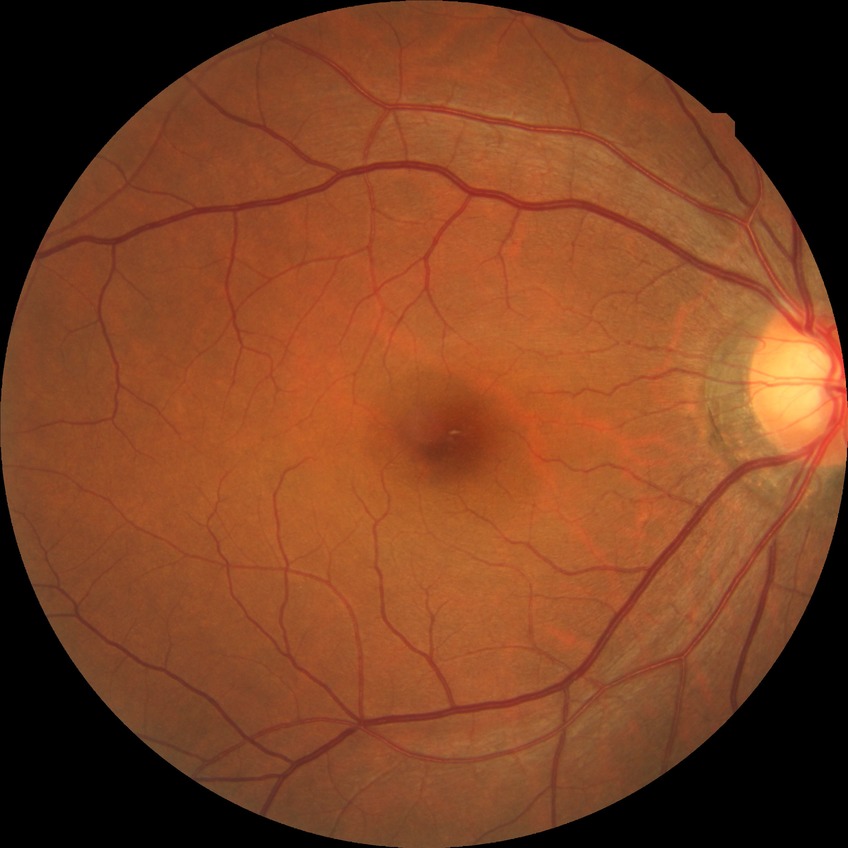

* diabetic retinopathy (DR): NDR (no diabetic retinopathy)